Color fundus photograph. 1936x1296. FOV: 45 degrees
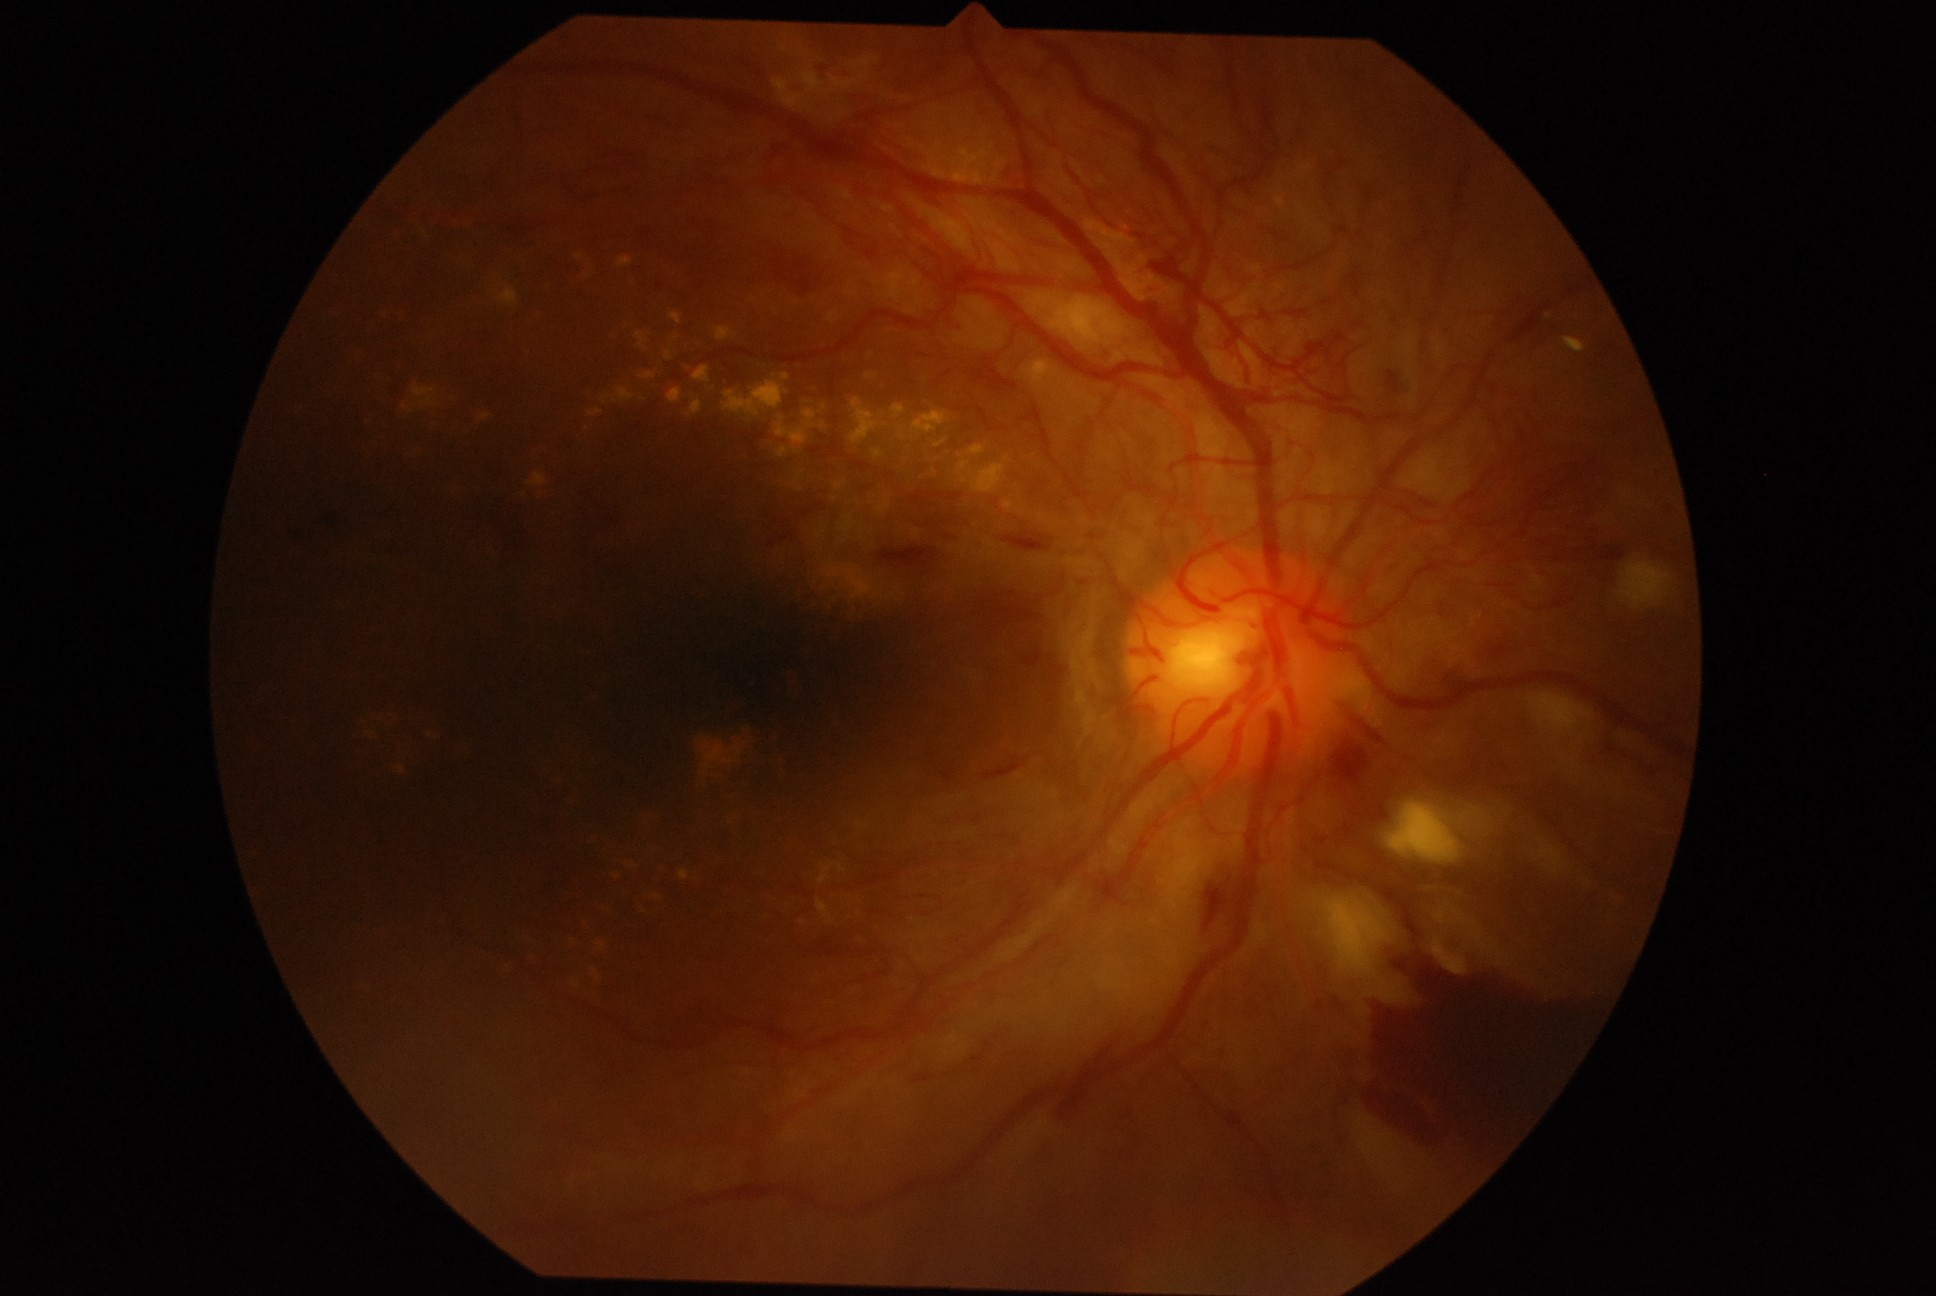
DR stage: grade 4 (PDR).